45° field of view. Image size 848x848
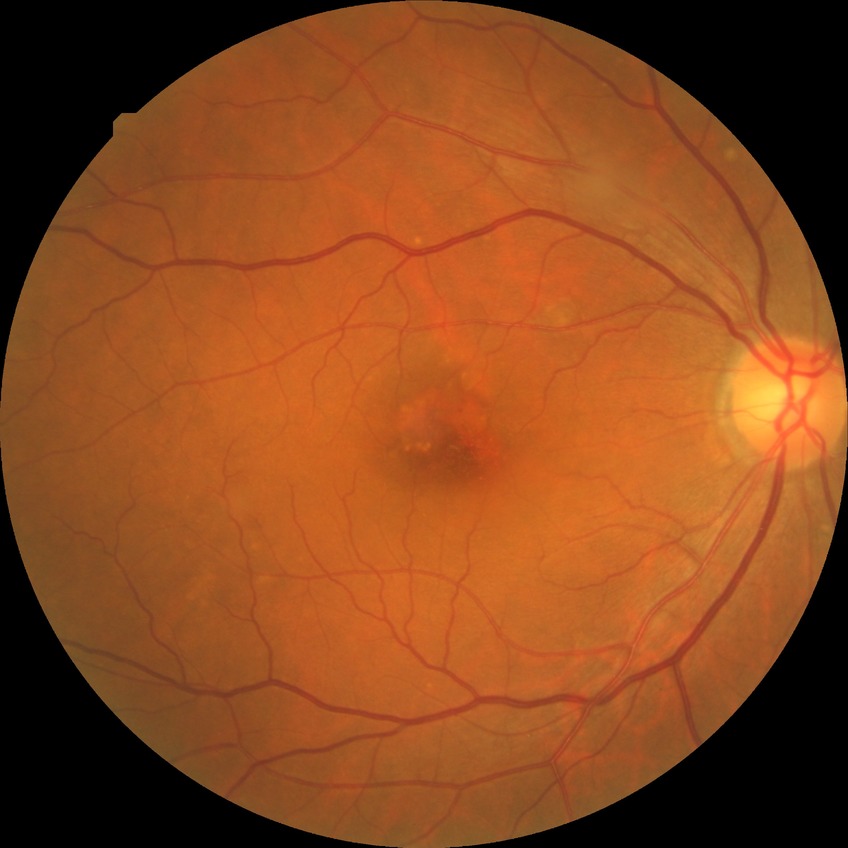
Assessment:
* retinopathy grade — simple diabetic retinopathy